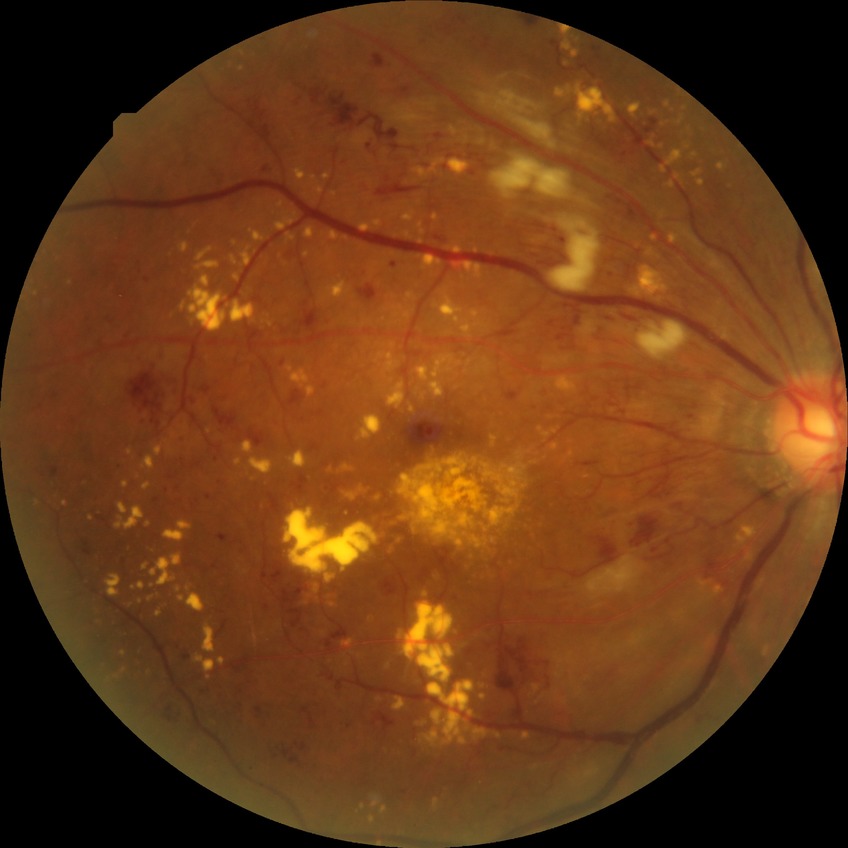
Diabetic retinopathy (DR) is proliferative diabetic retinopathy (PDR).